Without pupil dilation; 848x848; retinal fundus photograph; NIDEK AFC-230 fundus camera; 45-degree field of view
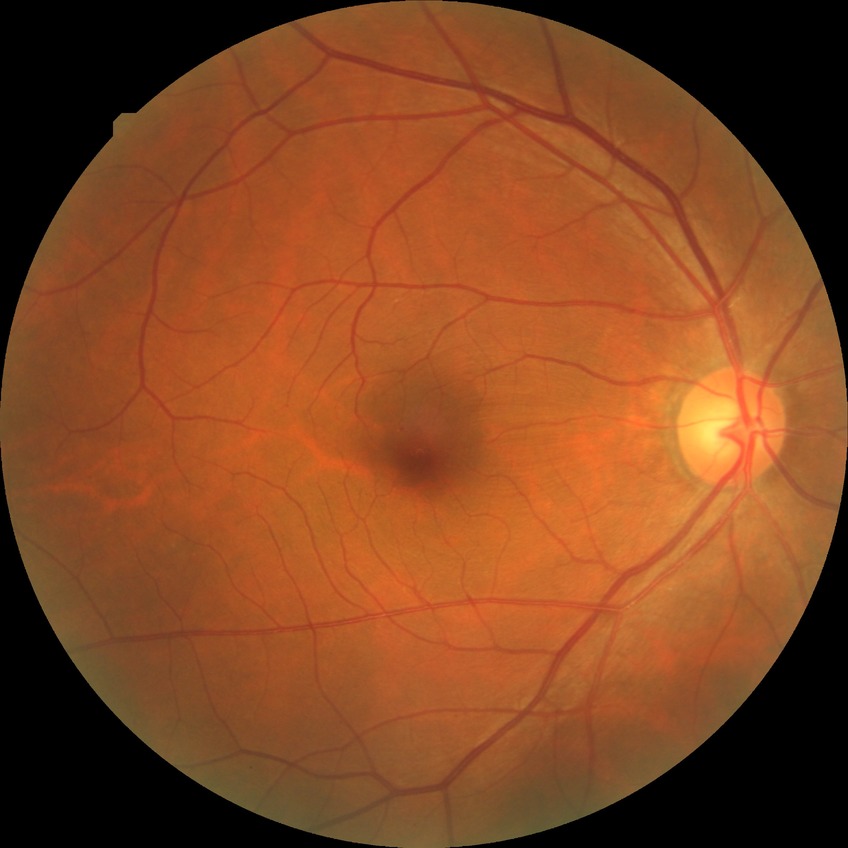 diabetic retinopathy (DR)@simple diabetic retinopathy (SDR).